45° FOV. 2212x1659. CFP — 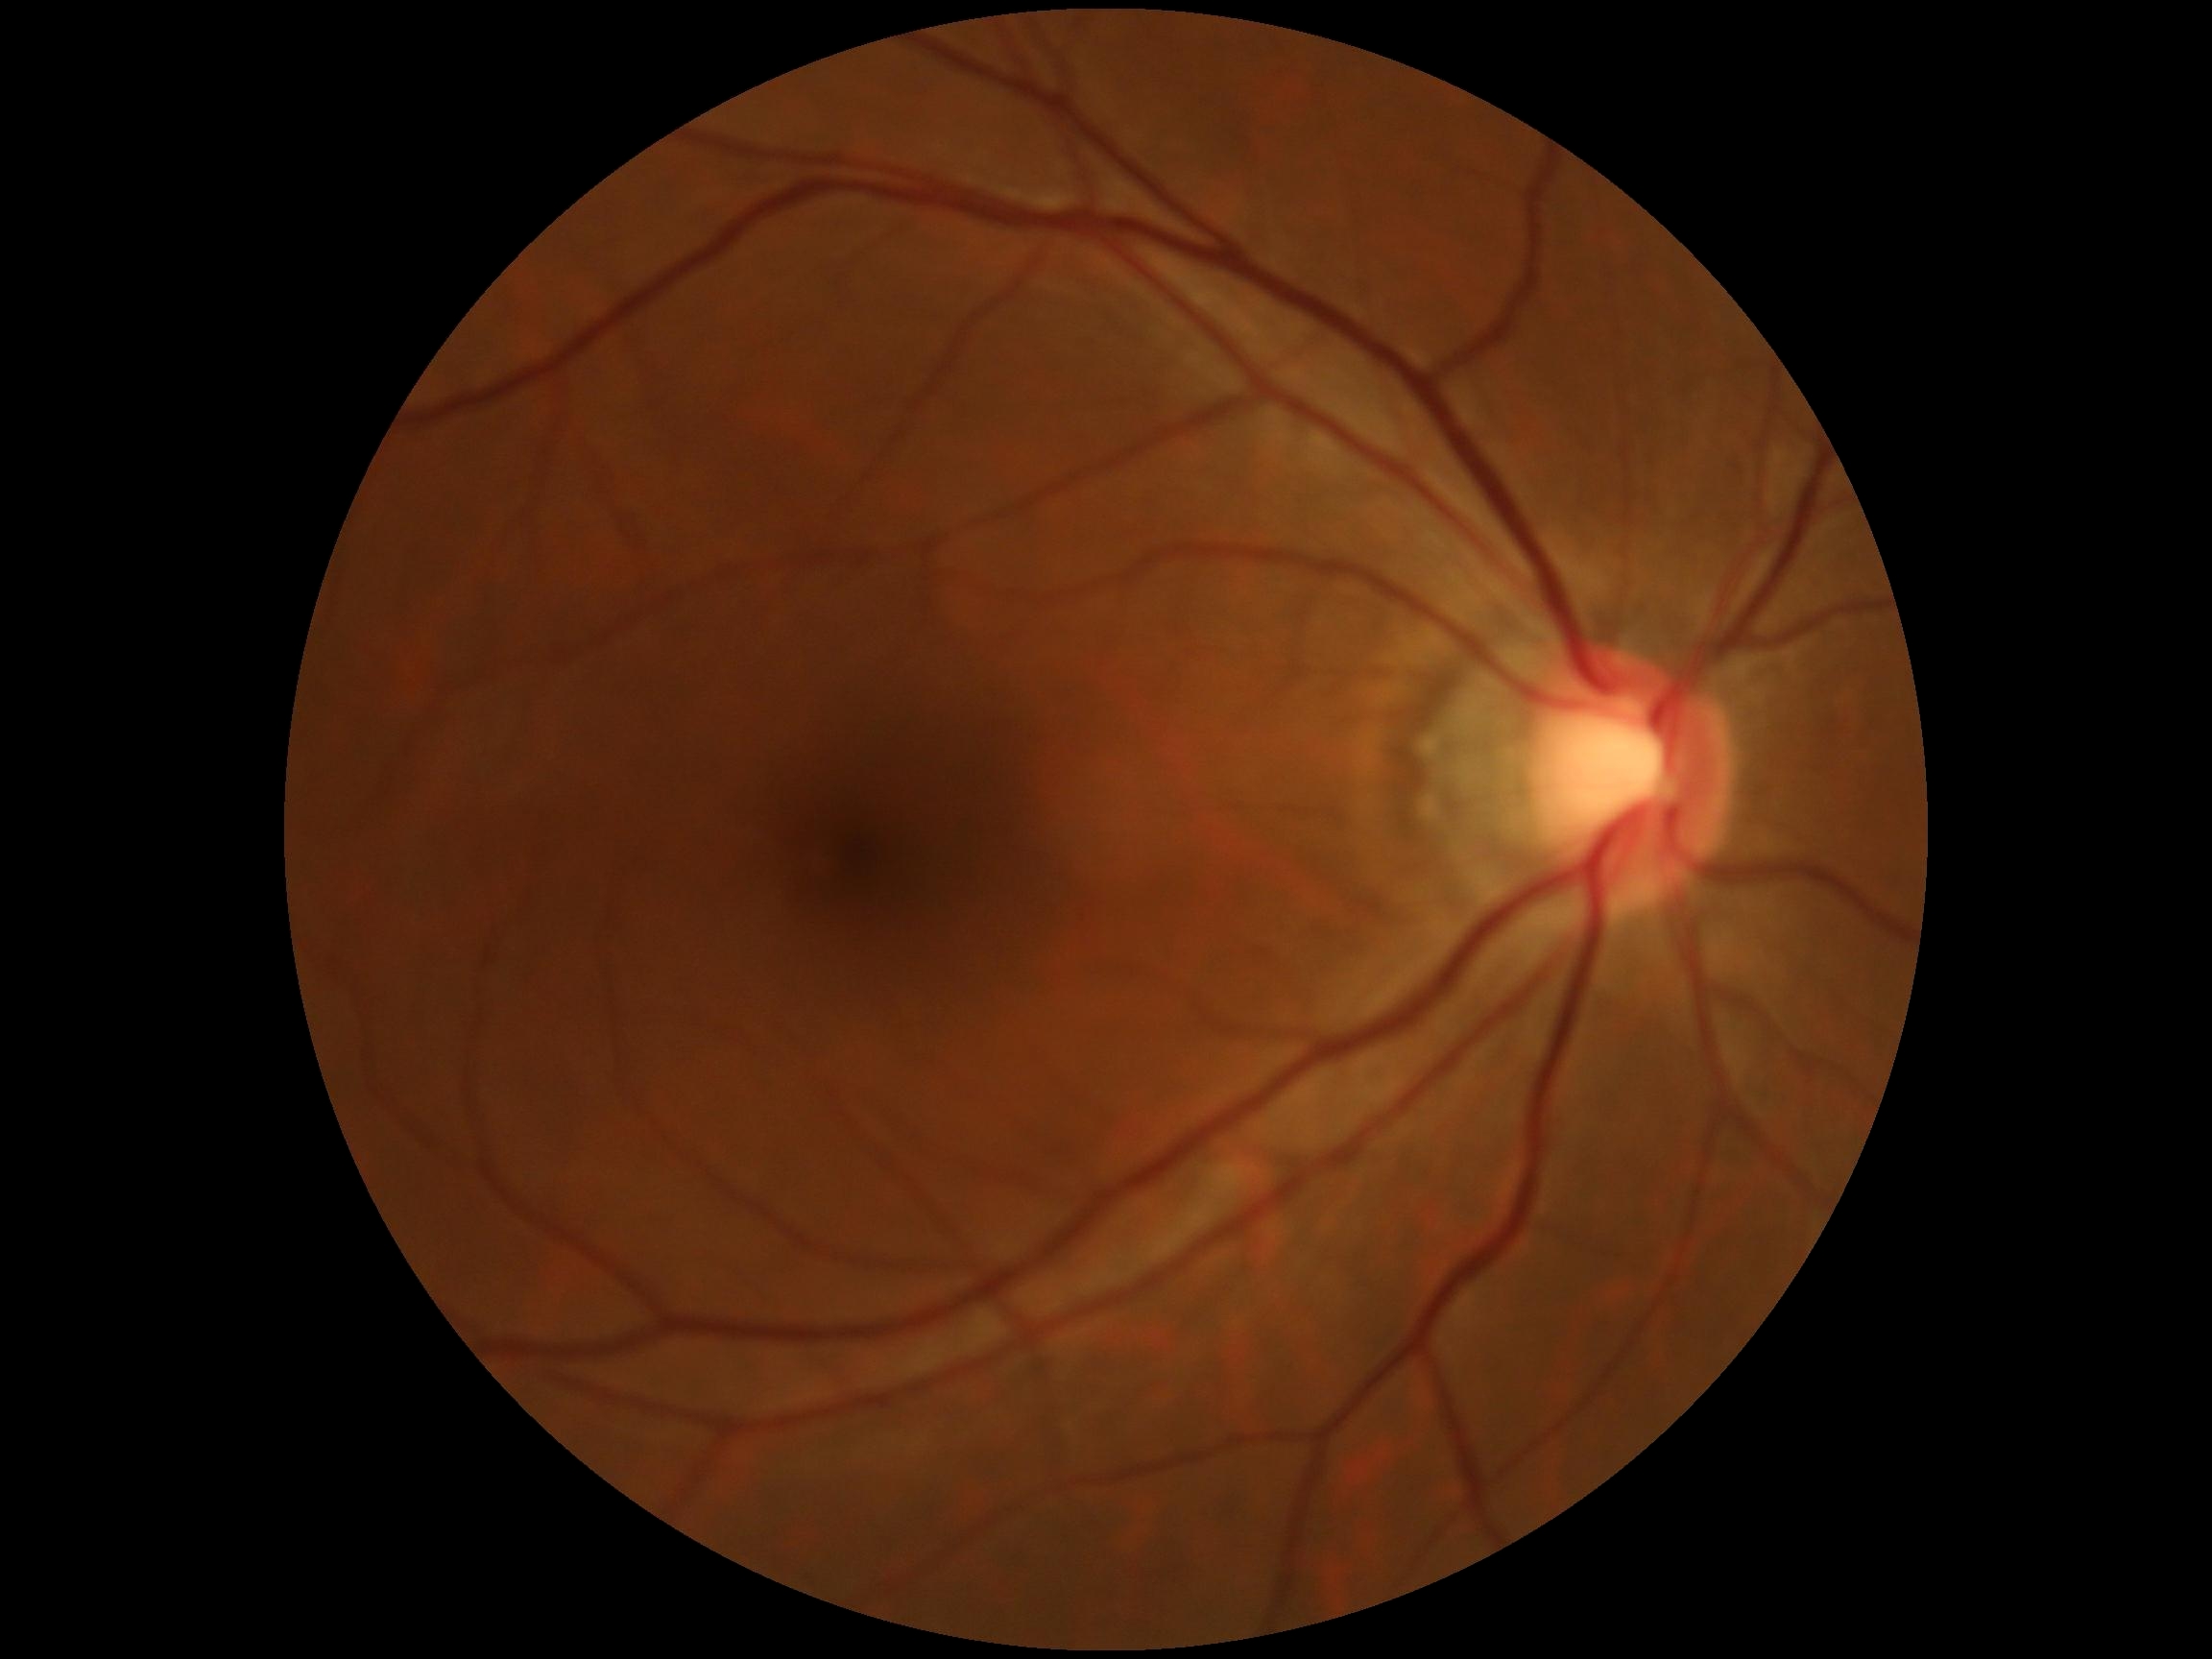 * retinopathy — grade 0 (no apparent retinopathy)